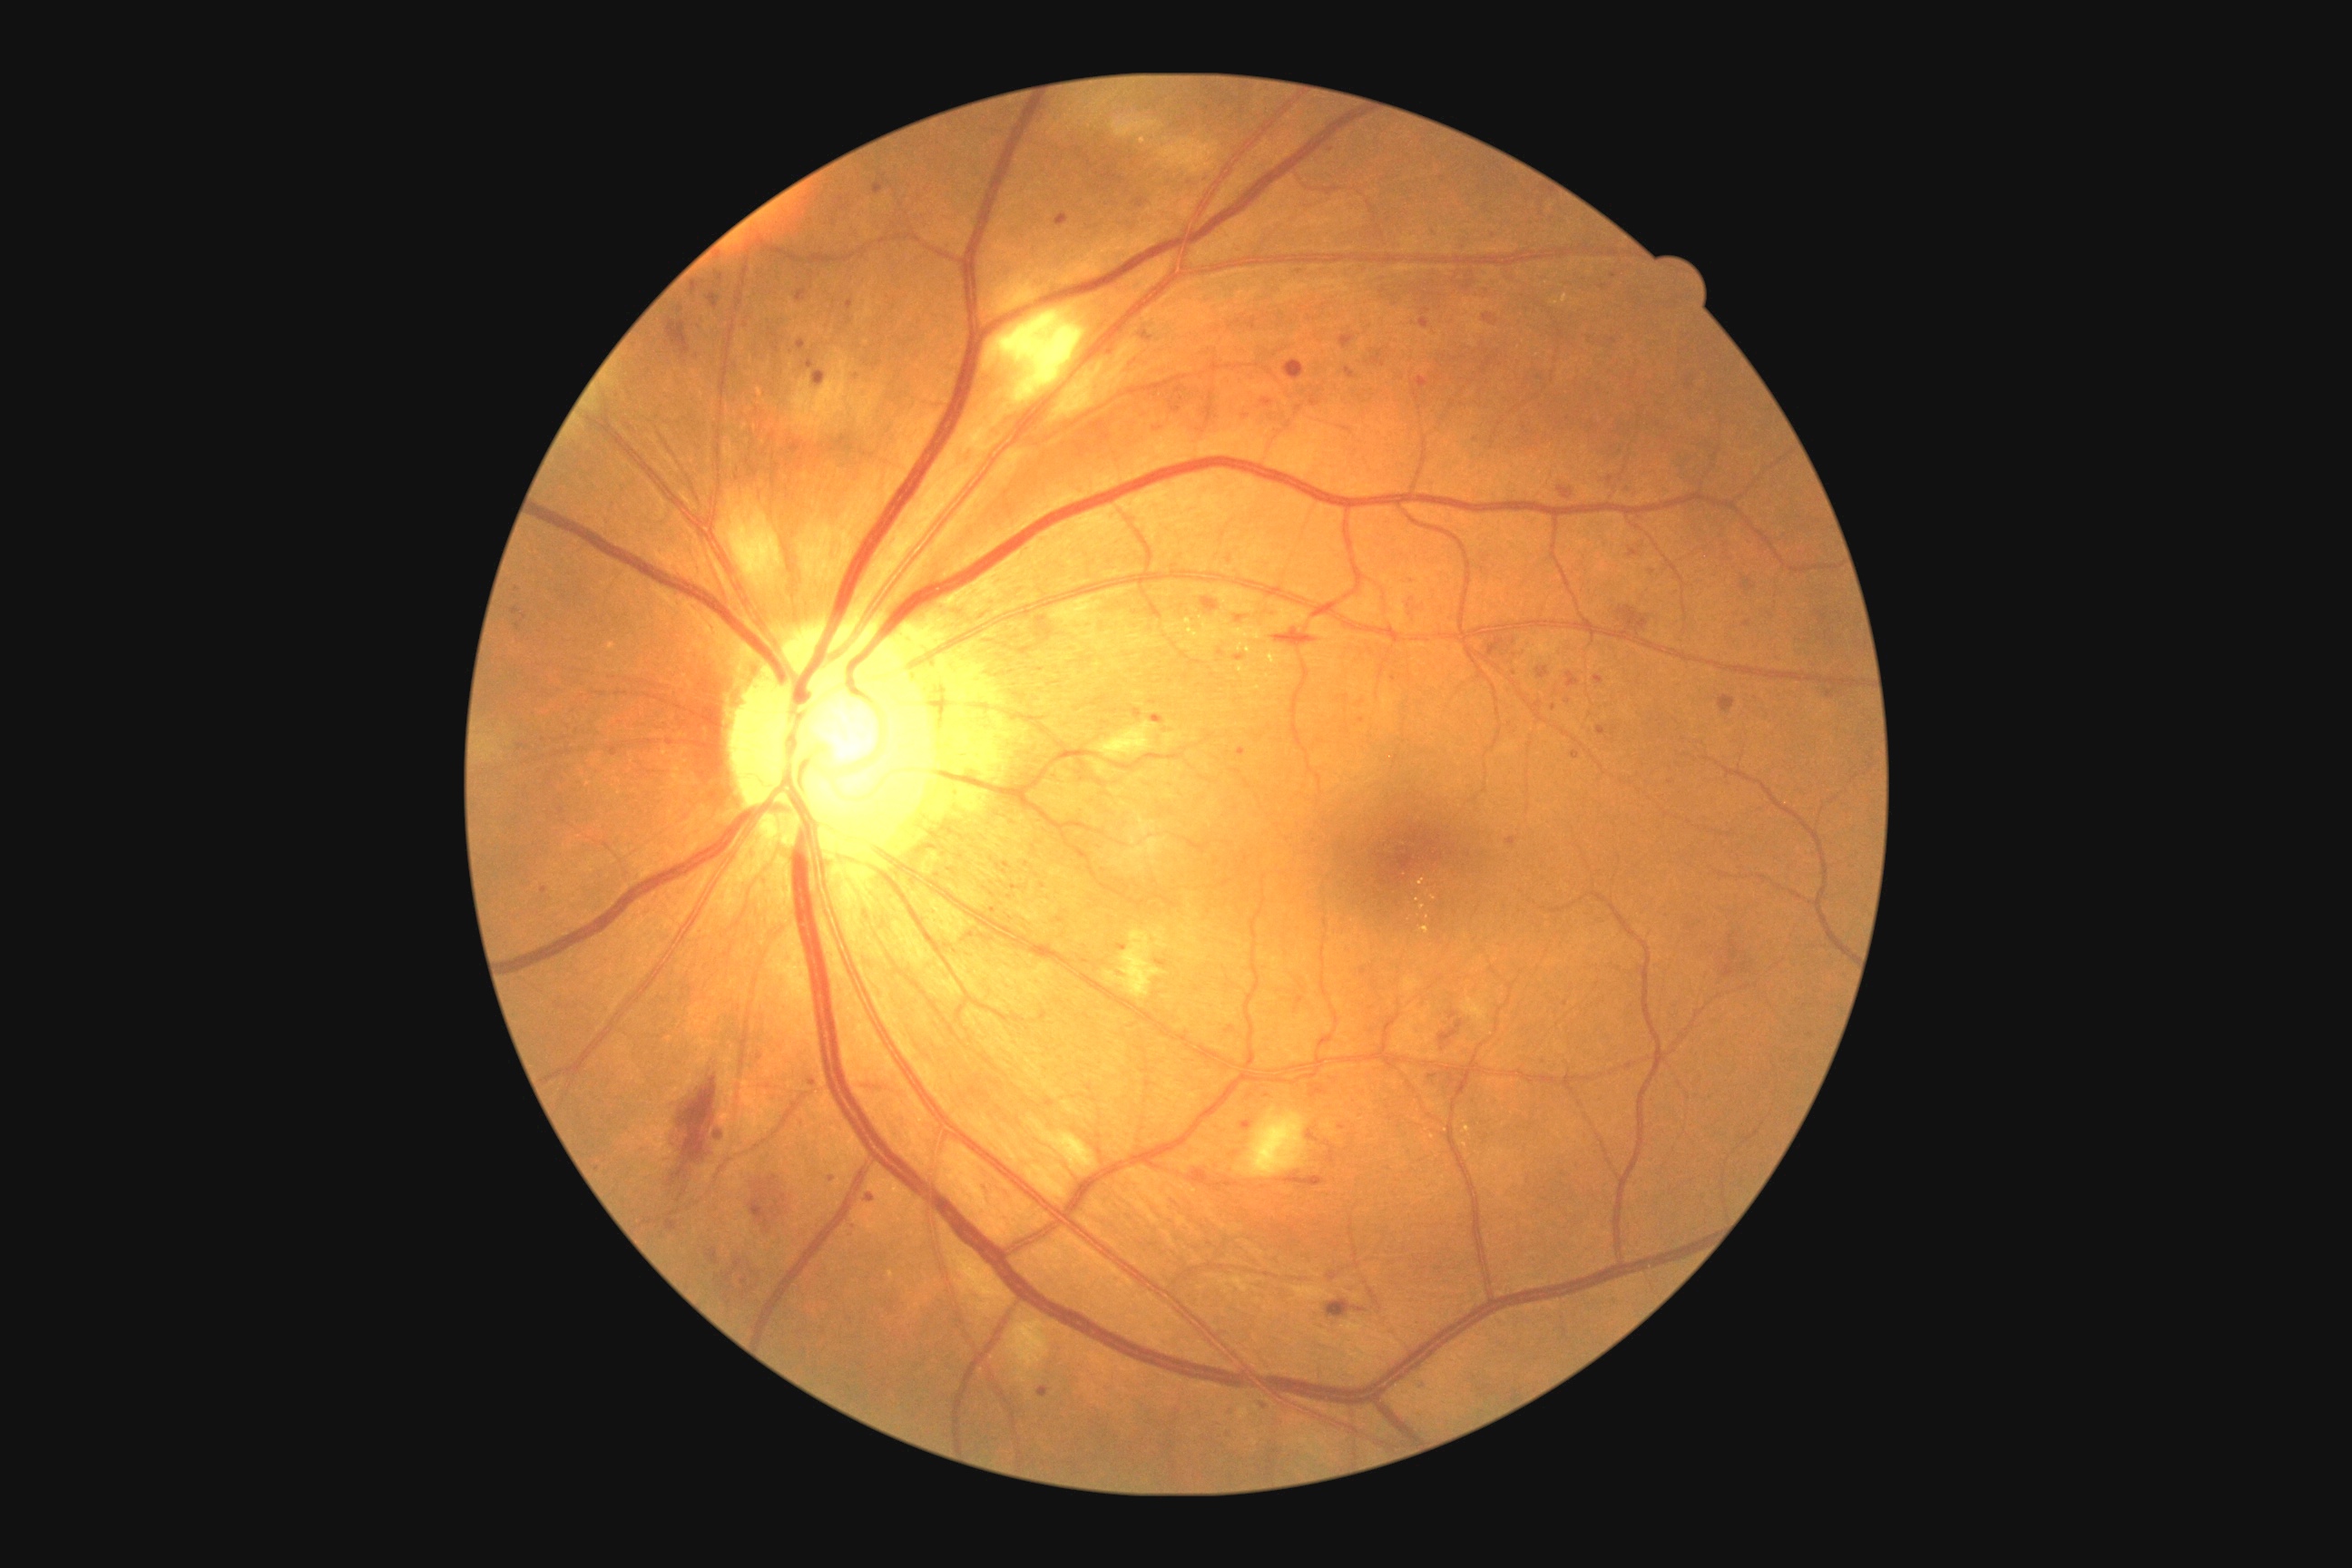
{"partial": true, "dr_grade": 2, "lesions": {"ma": [[1607, 476, 1612, 484], [707, 1250, 720, 1266], [847, 300, 854, 309], [511, 609, 522, 616], [1235, 614, 1246, 623], [1081, 959, 1090, 965], [1235, 656, 1246, 662], [1155, 961, 1168, 968], [714, 271, 725, 286], [1344, 368, 1358, 380], [1237, 747, 1248, 758], [874, 175, 890, 197], [1505, 838, 1518, 847]], "ma_small_approx": [[1565, 1004], [1231, 1412], [1264, 1407], [831, 1179], [1321, 741], [1158, 429], [1568, 702]]}}